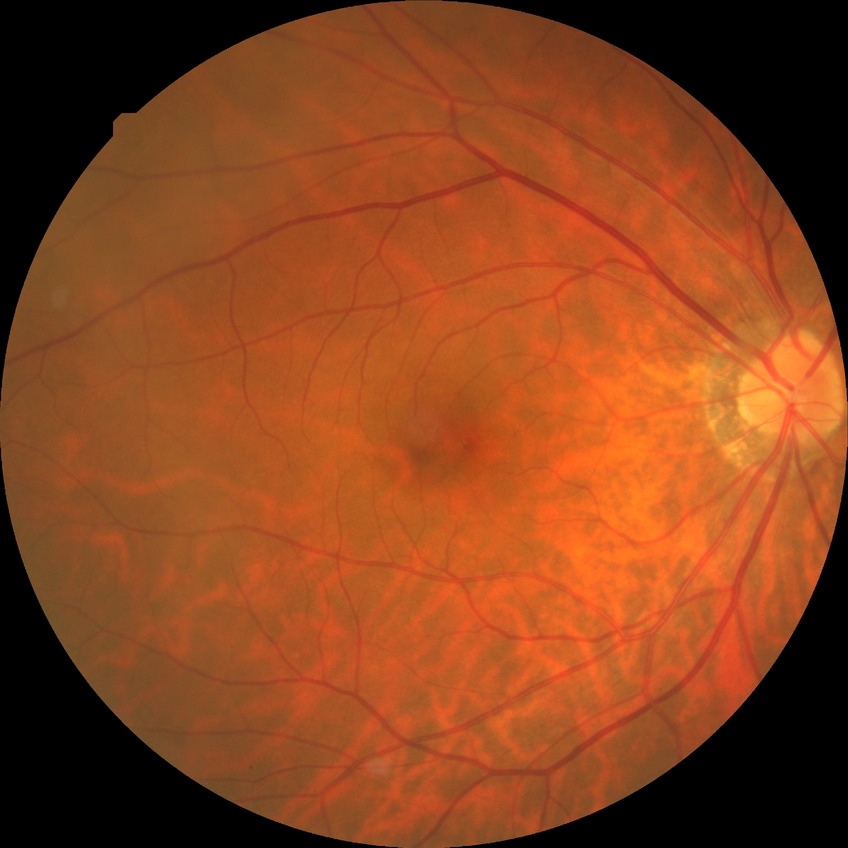

Diabetic retinopathy (DR) is NDR (no diabetic retinopathy).